45 degree fundus photograph, posterior pole color fundus photograph: 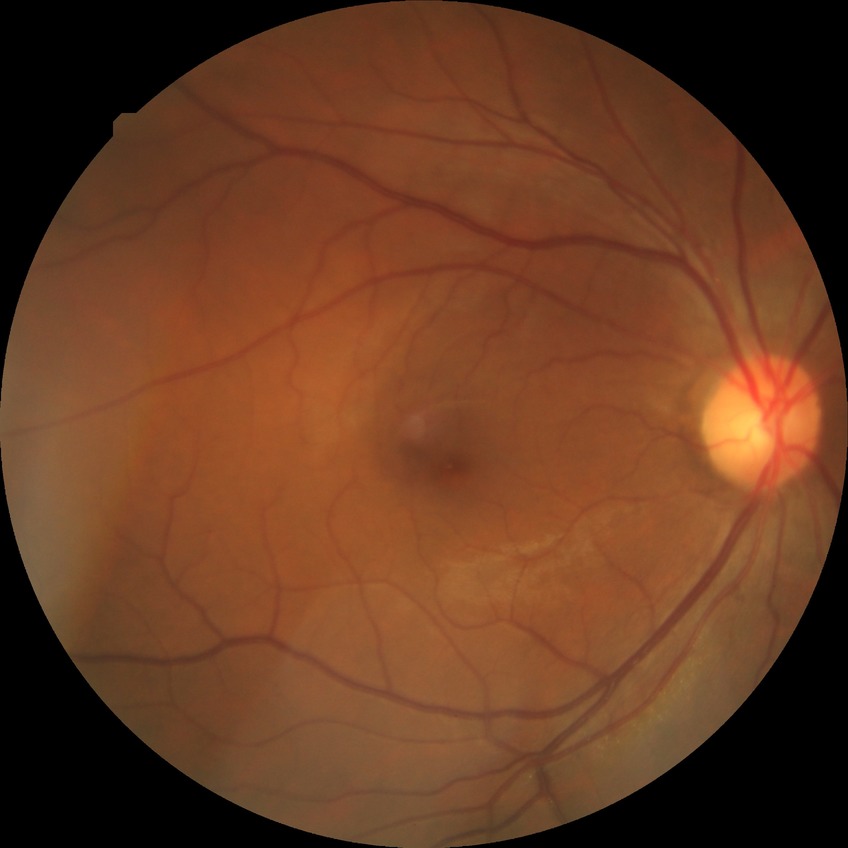   davis_grade: no diabetic retinopathy (NDR)